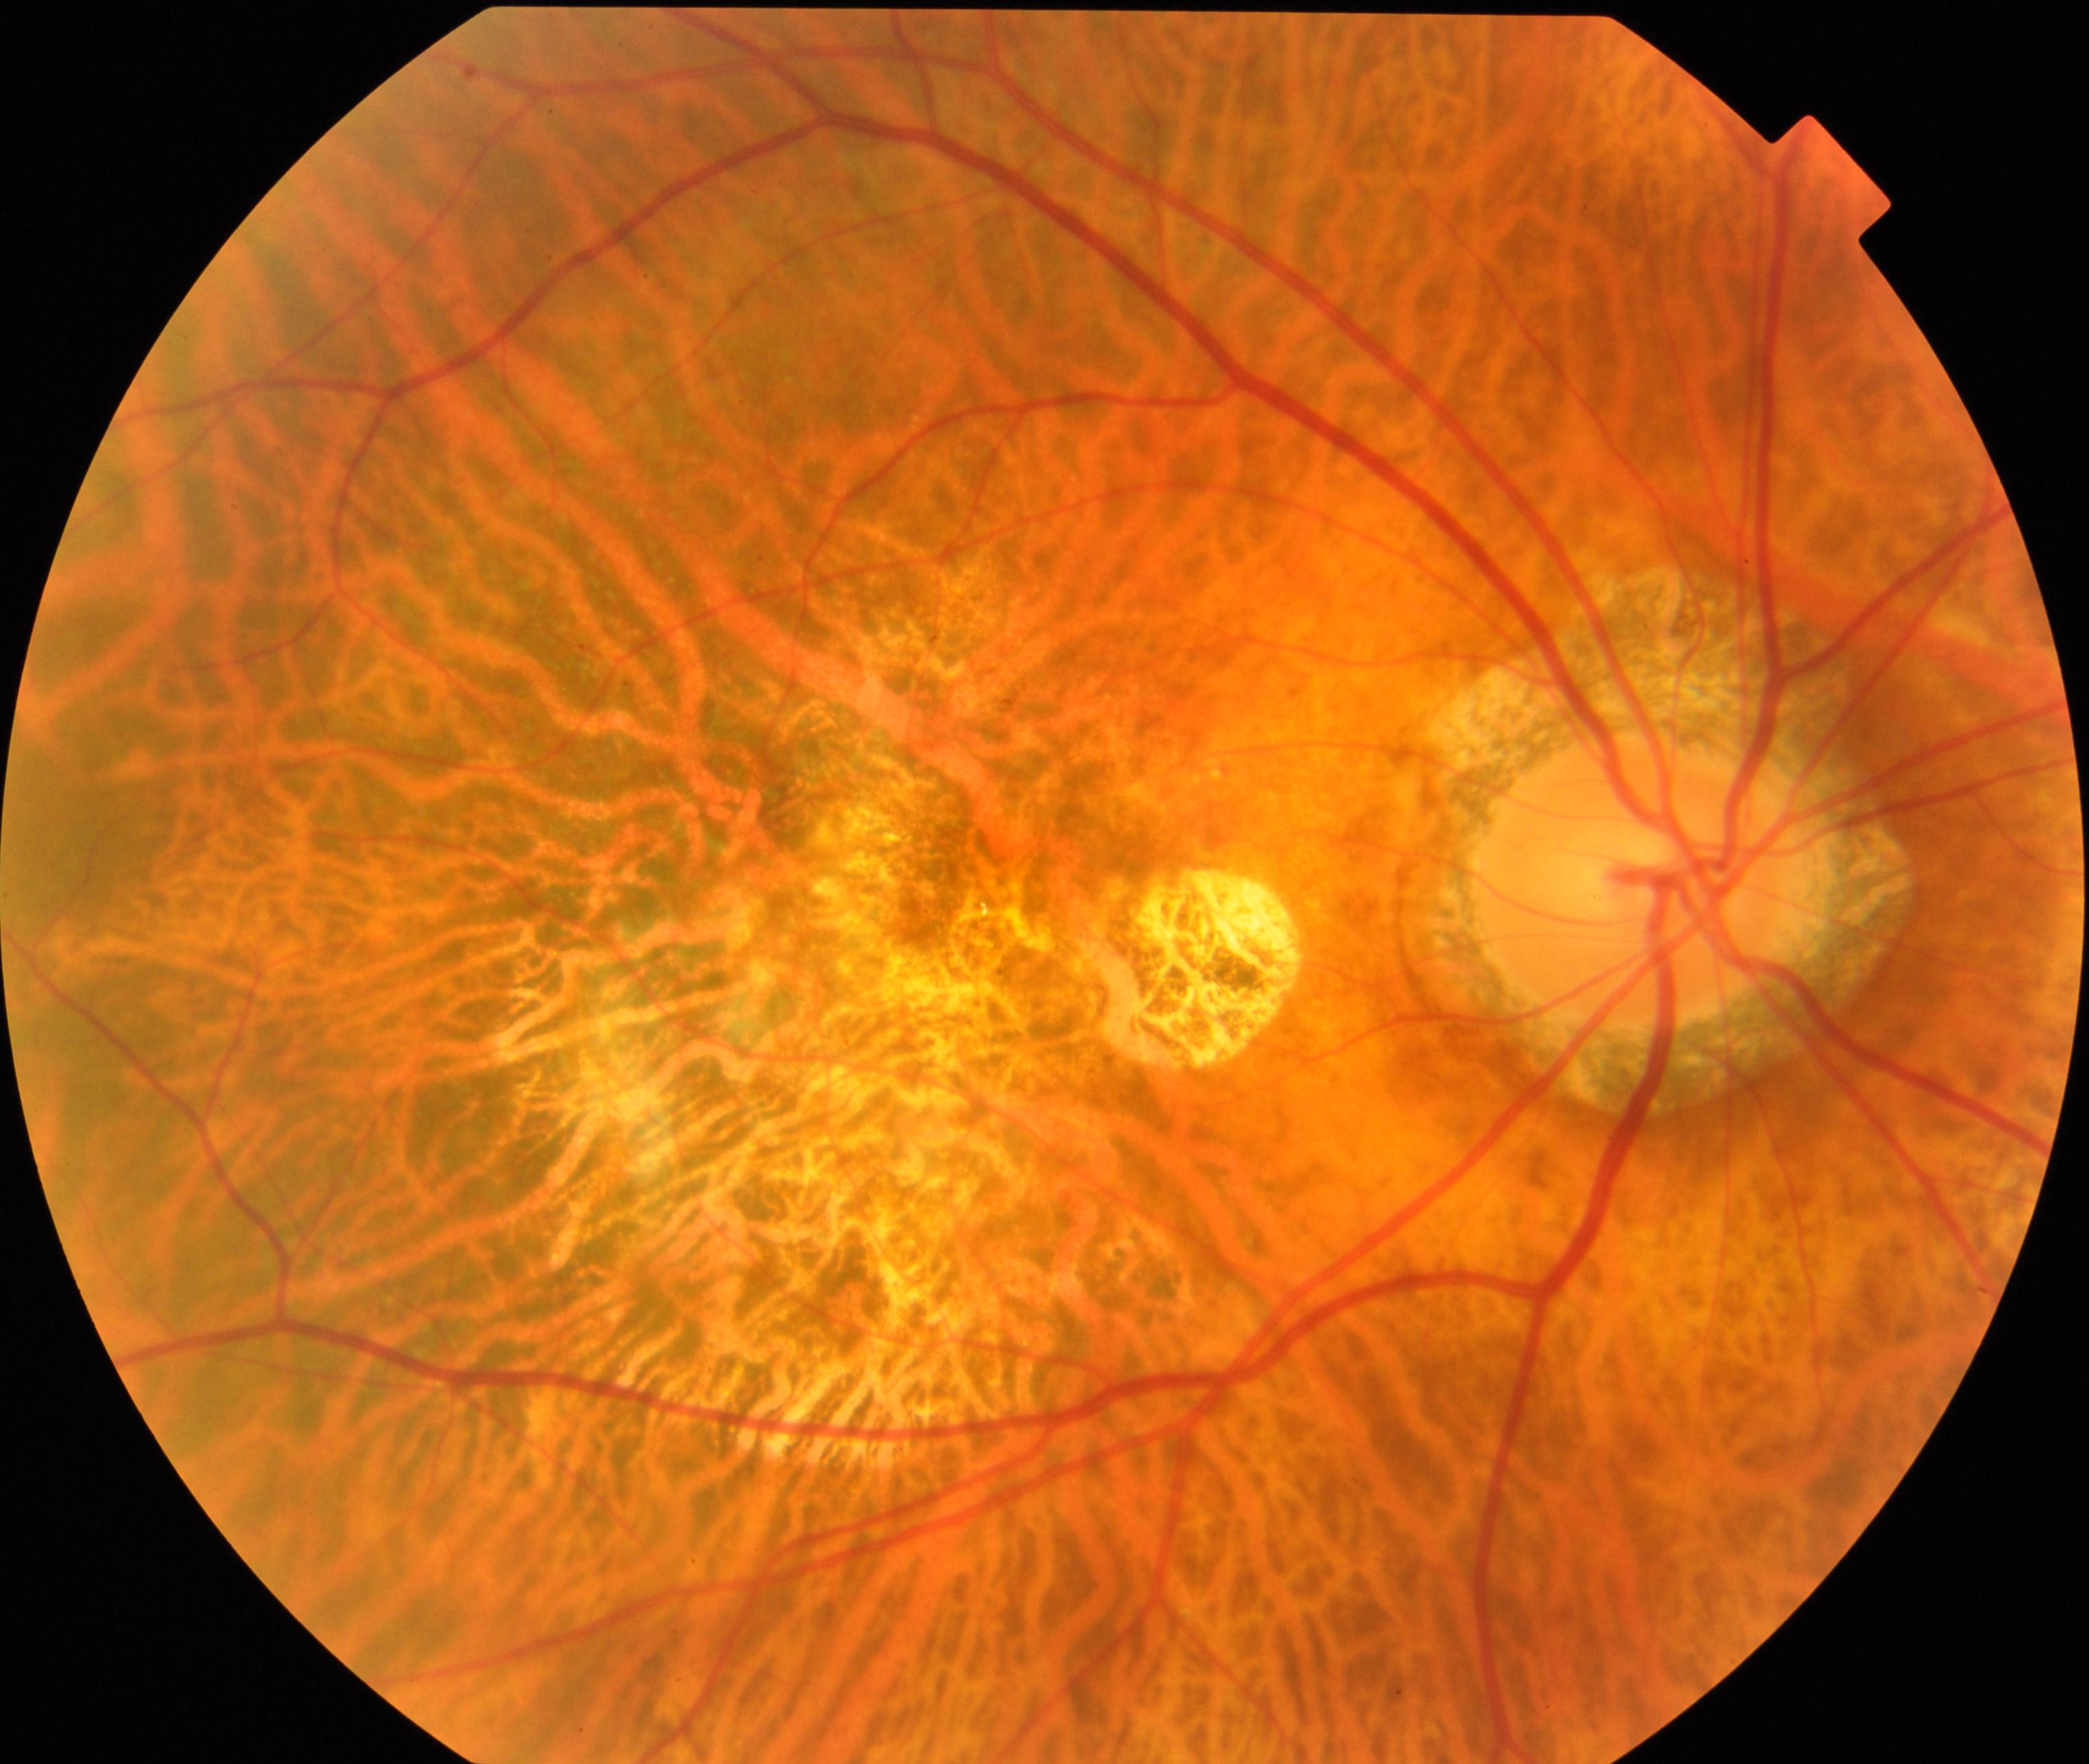
Consistent with pathological myopia.